Pediatric retinal photograph (wide-field):
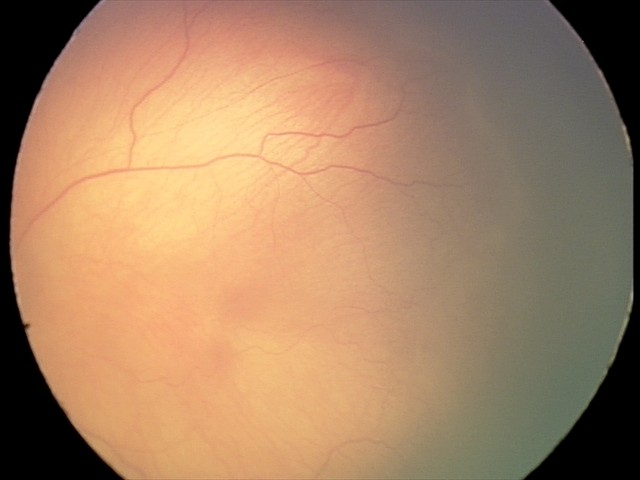 Screening series with retinopathy of prematurity (ROP) stage 1.